640 by 480 pixels; infant wide-field fundus photograph — 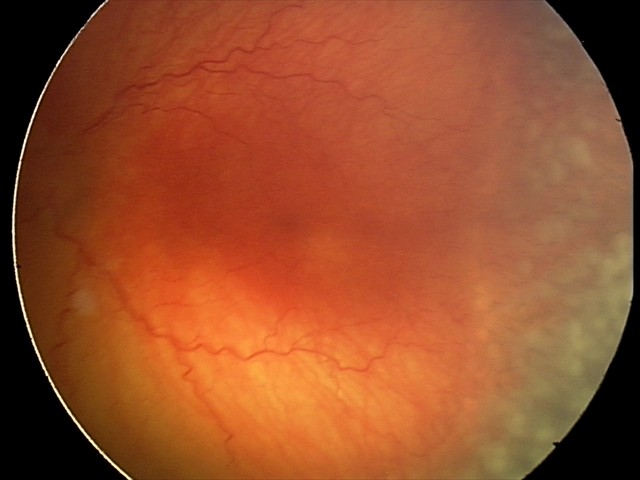 Diagnosis from this screening exam: aggressive retinopathy of prematurity (A-ROP). Plus disease was diagnosed.